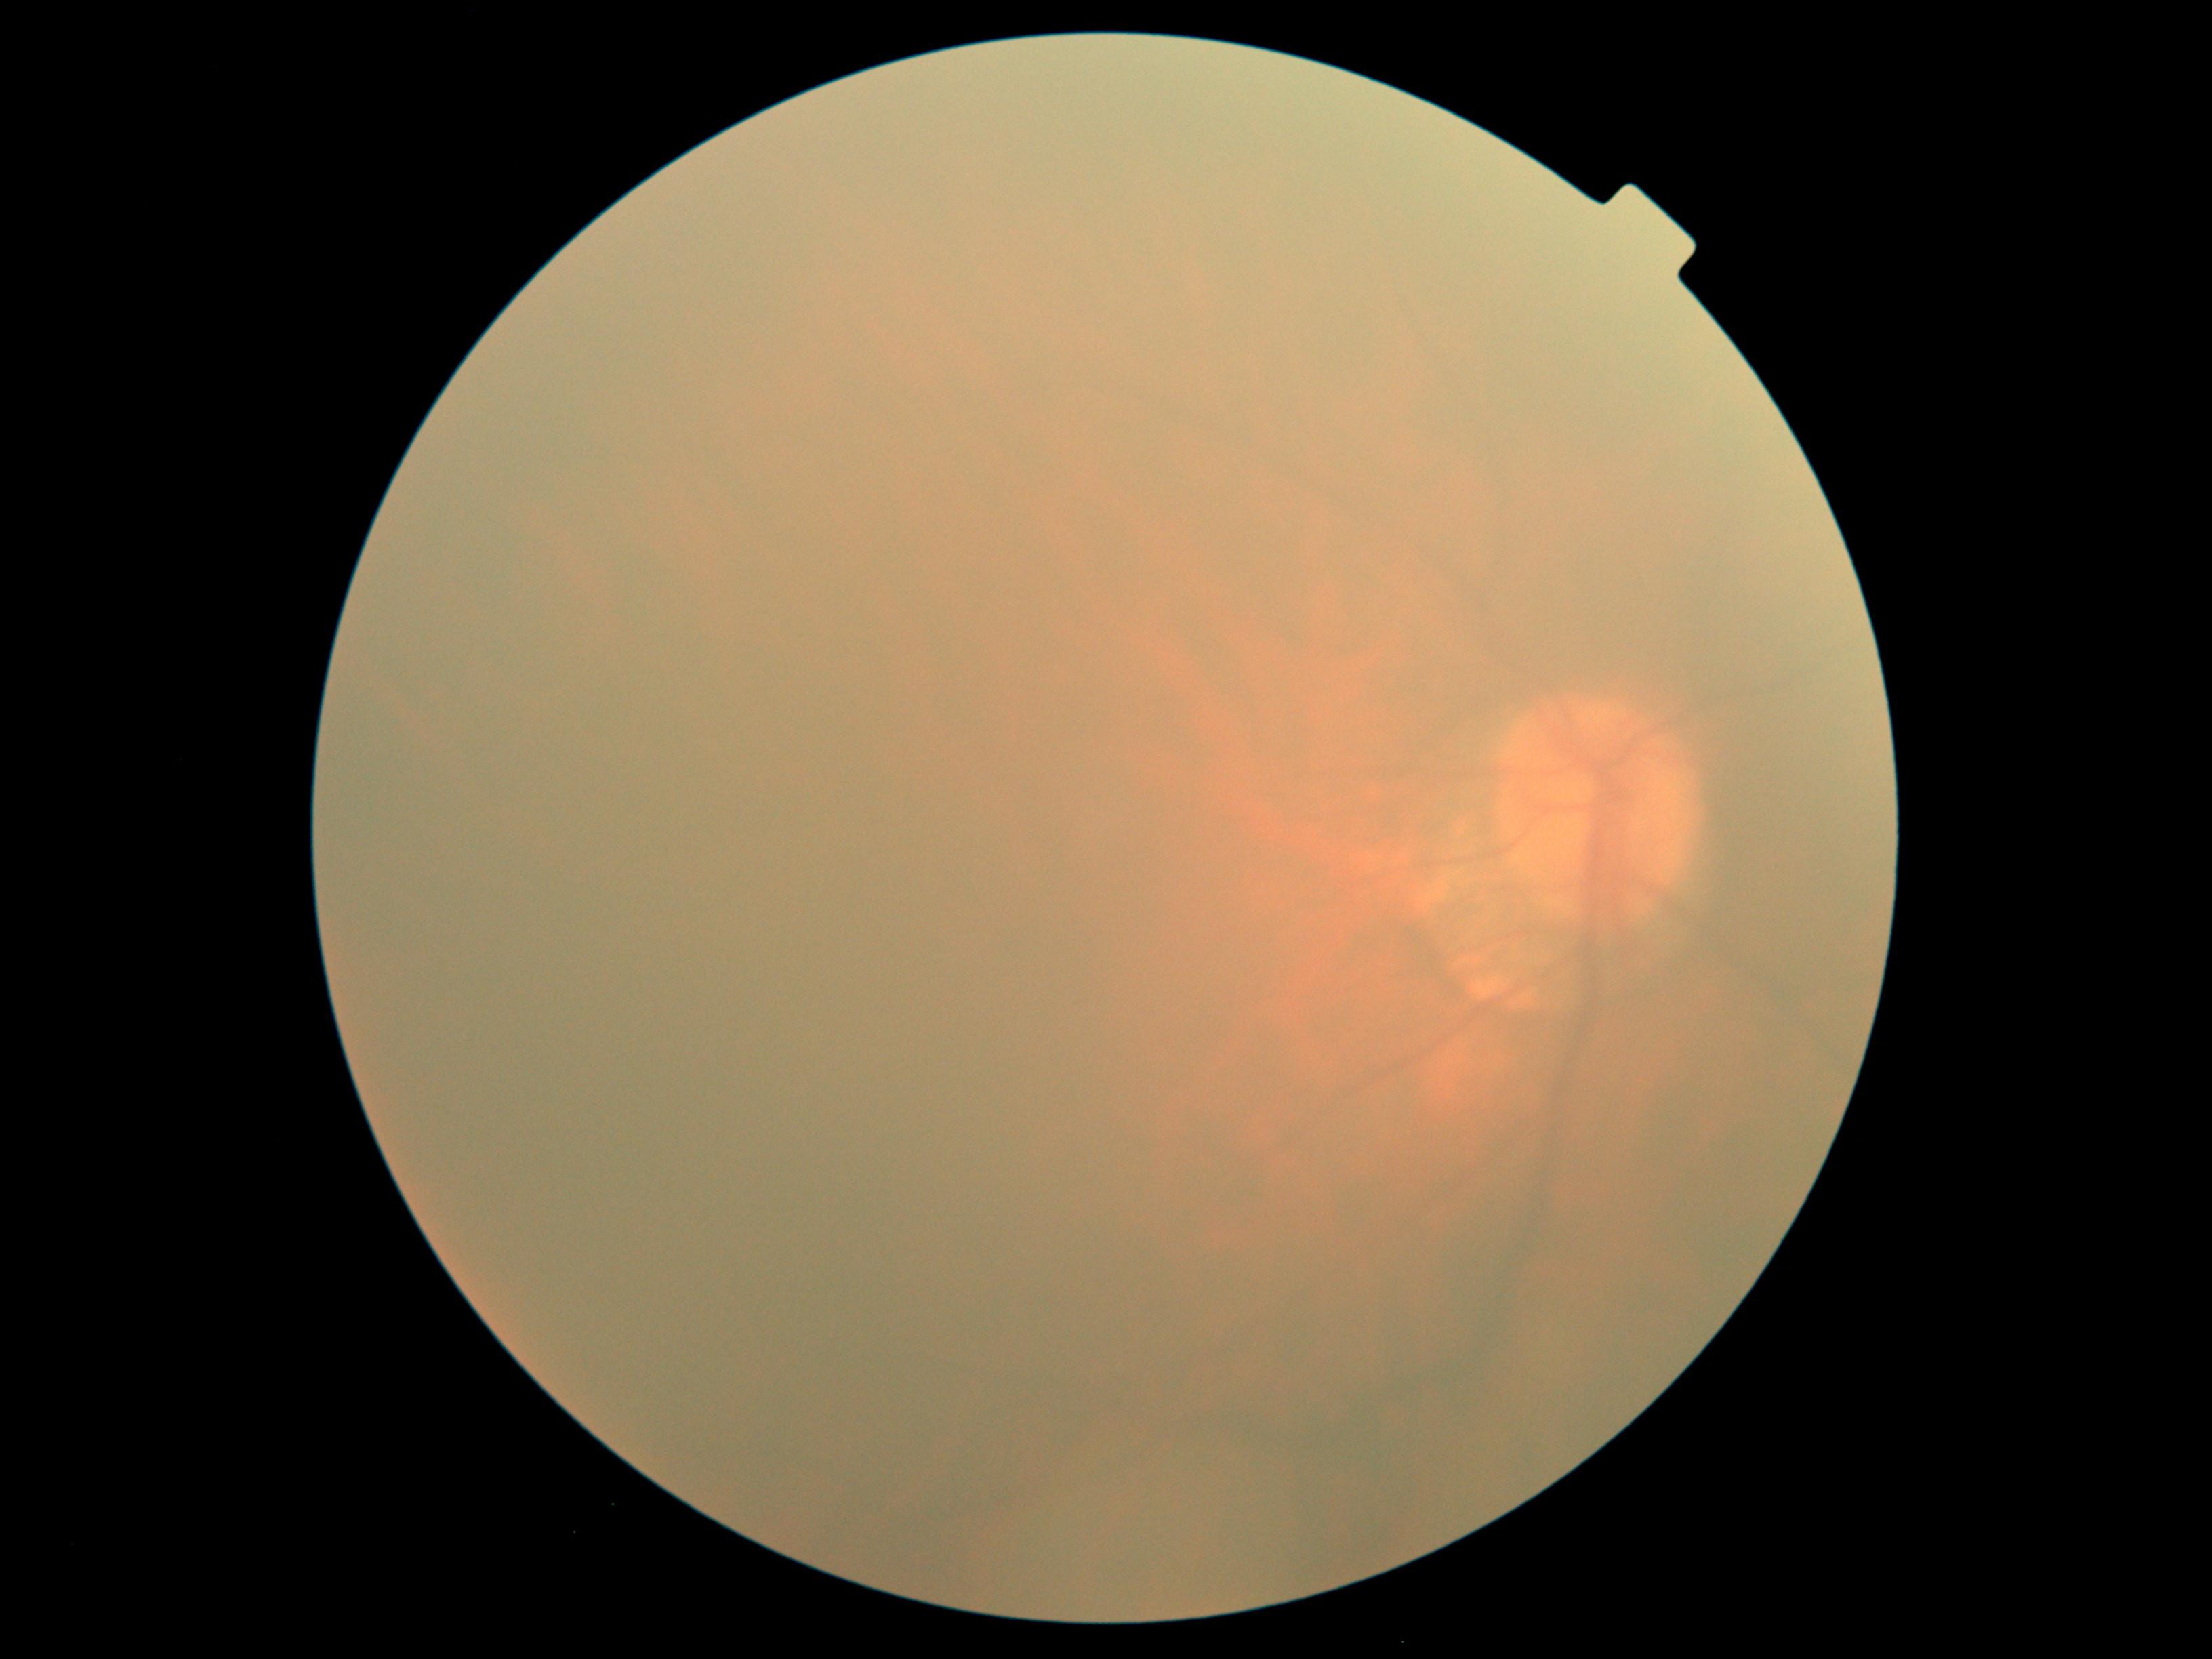

{
  "dr_grade": "ungradable due to poor image quality"
}